1240x1240px · pediatric retinal photograph (wide-field).
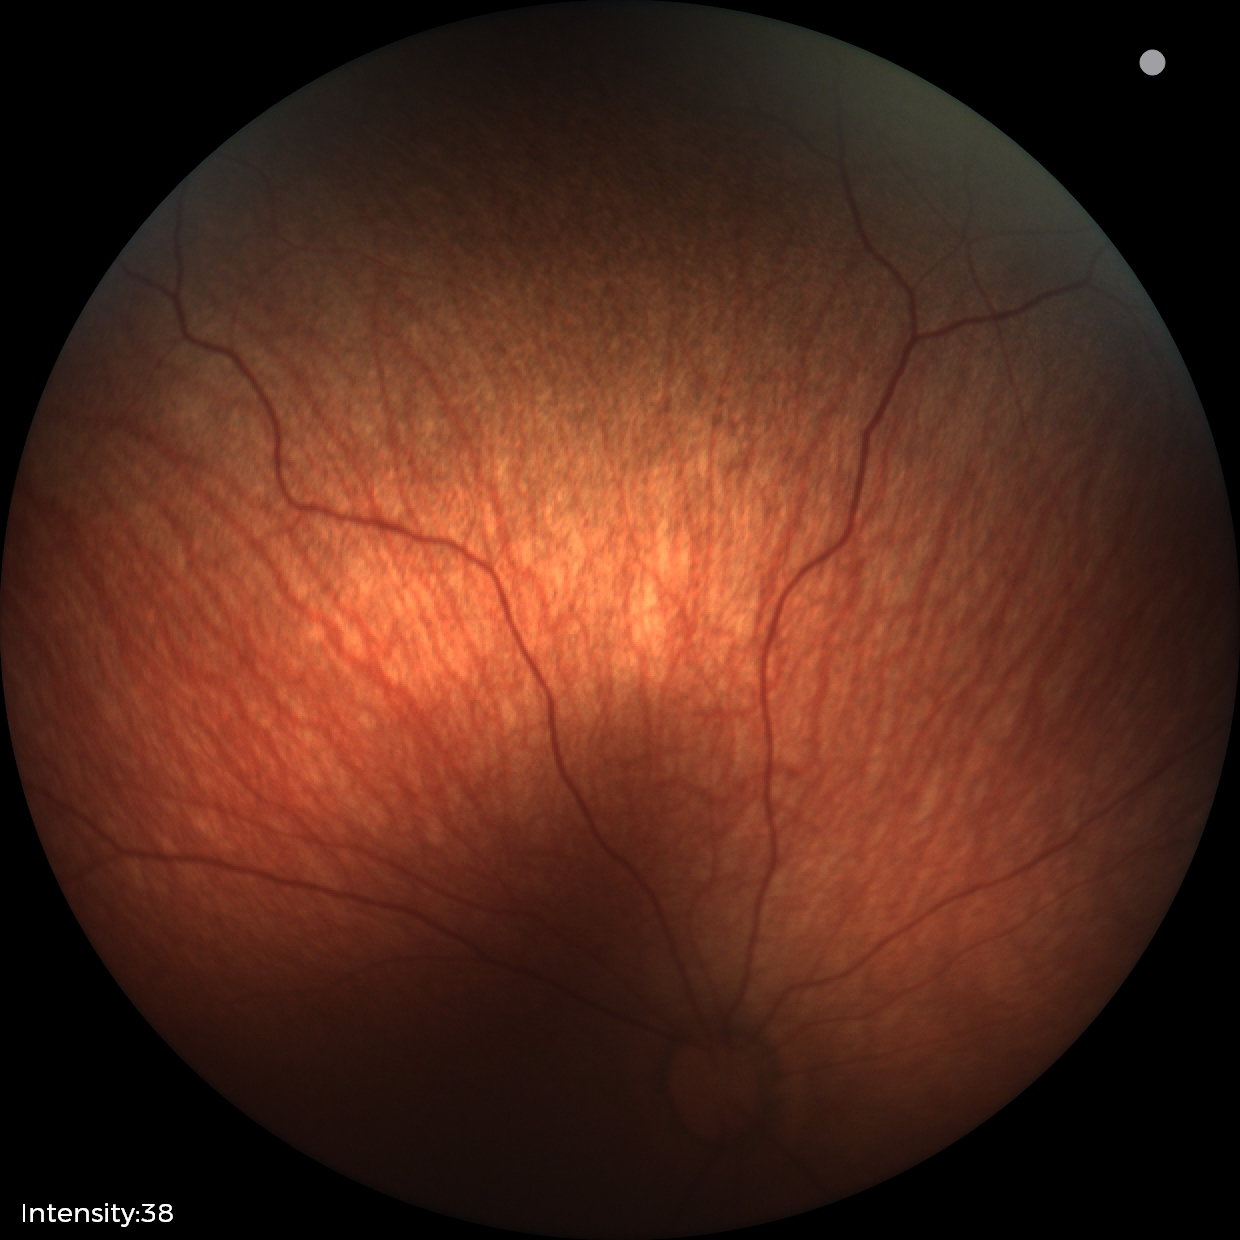 Assessment = physiological appearance.